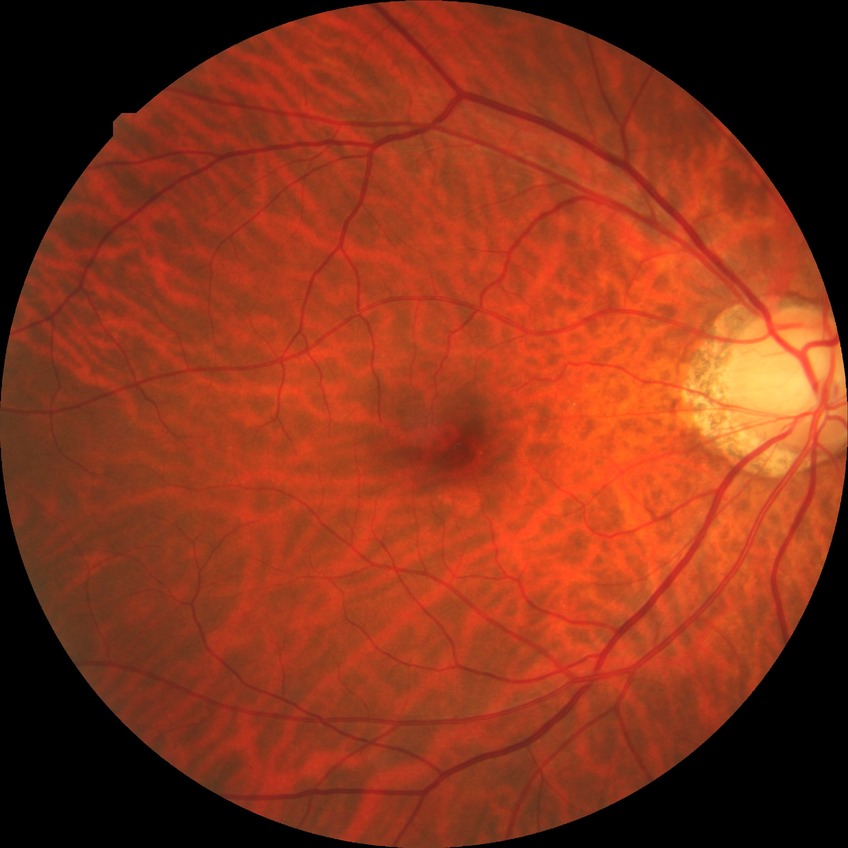 DR grade: NDR.